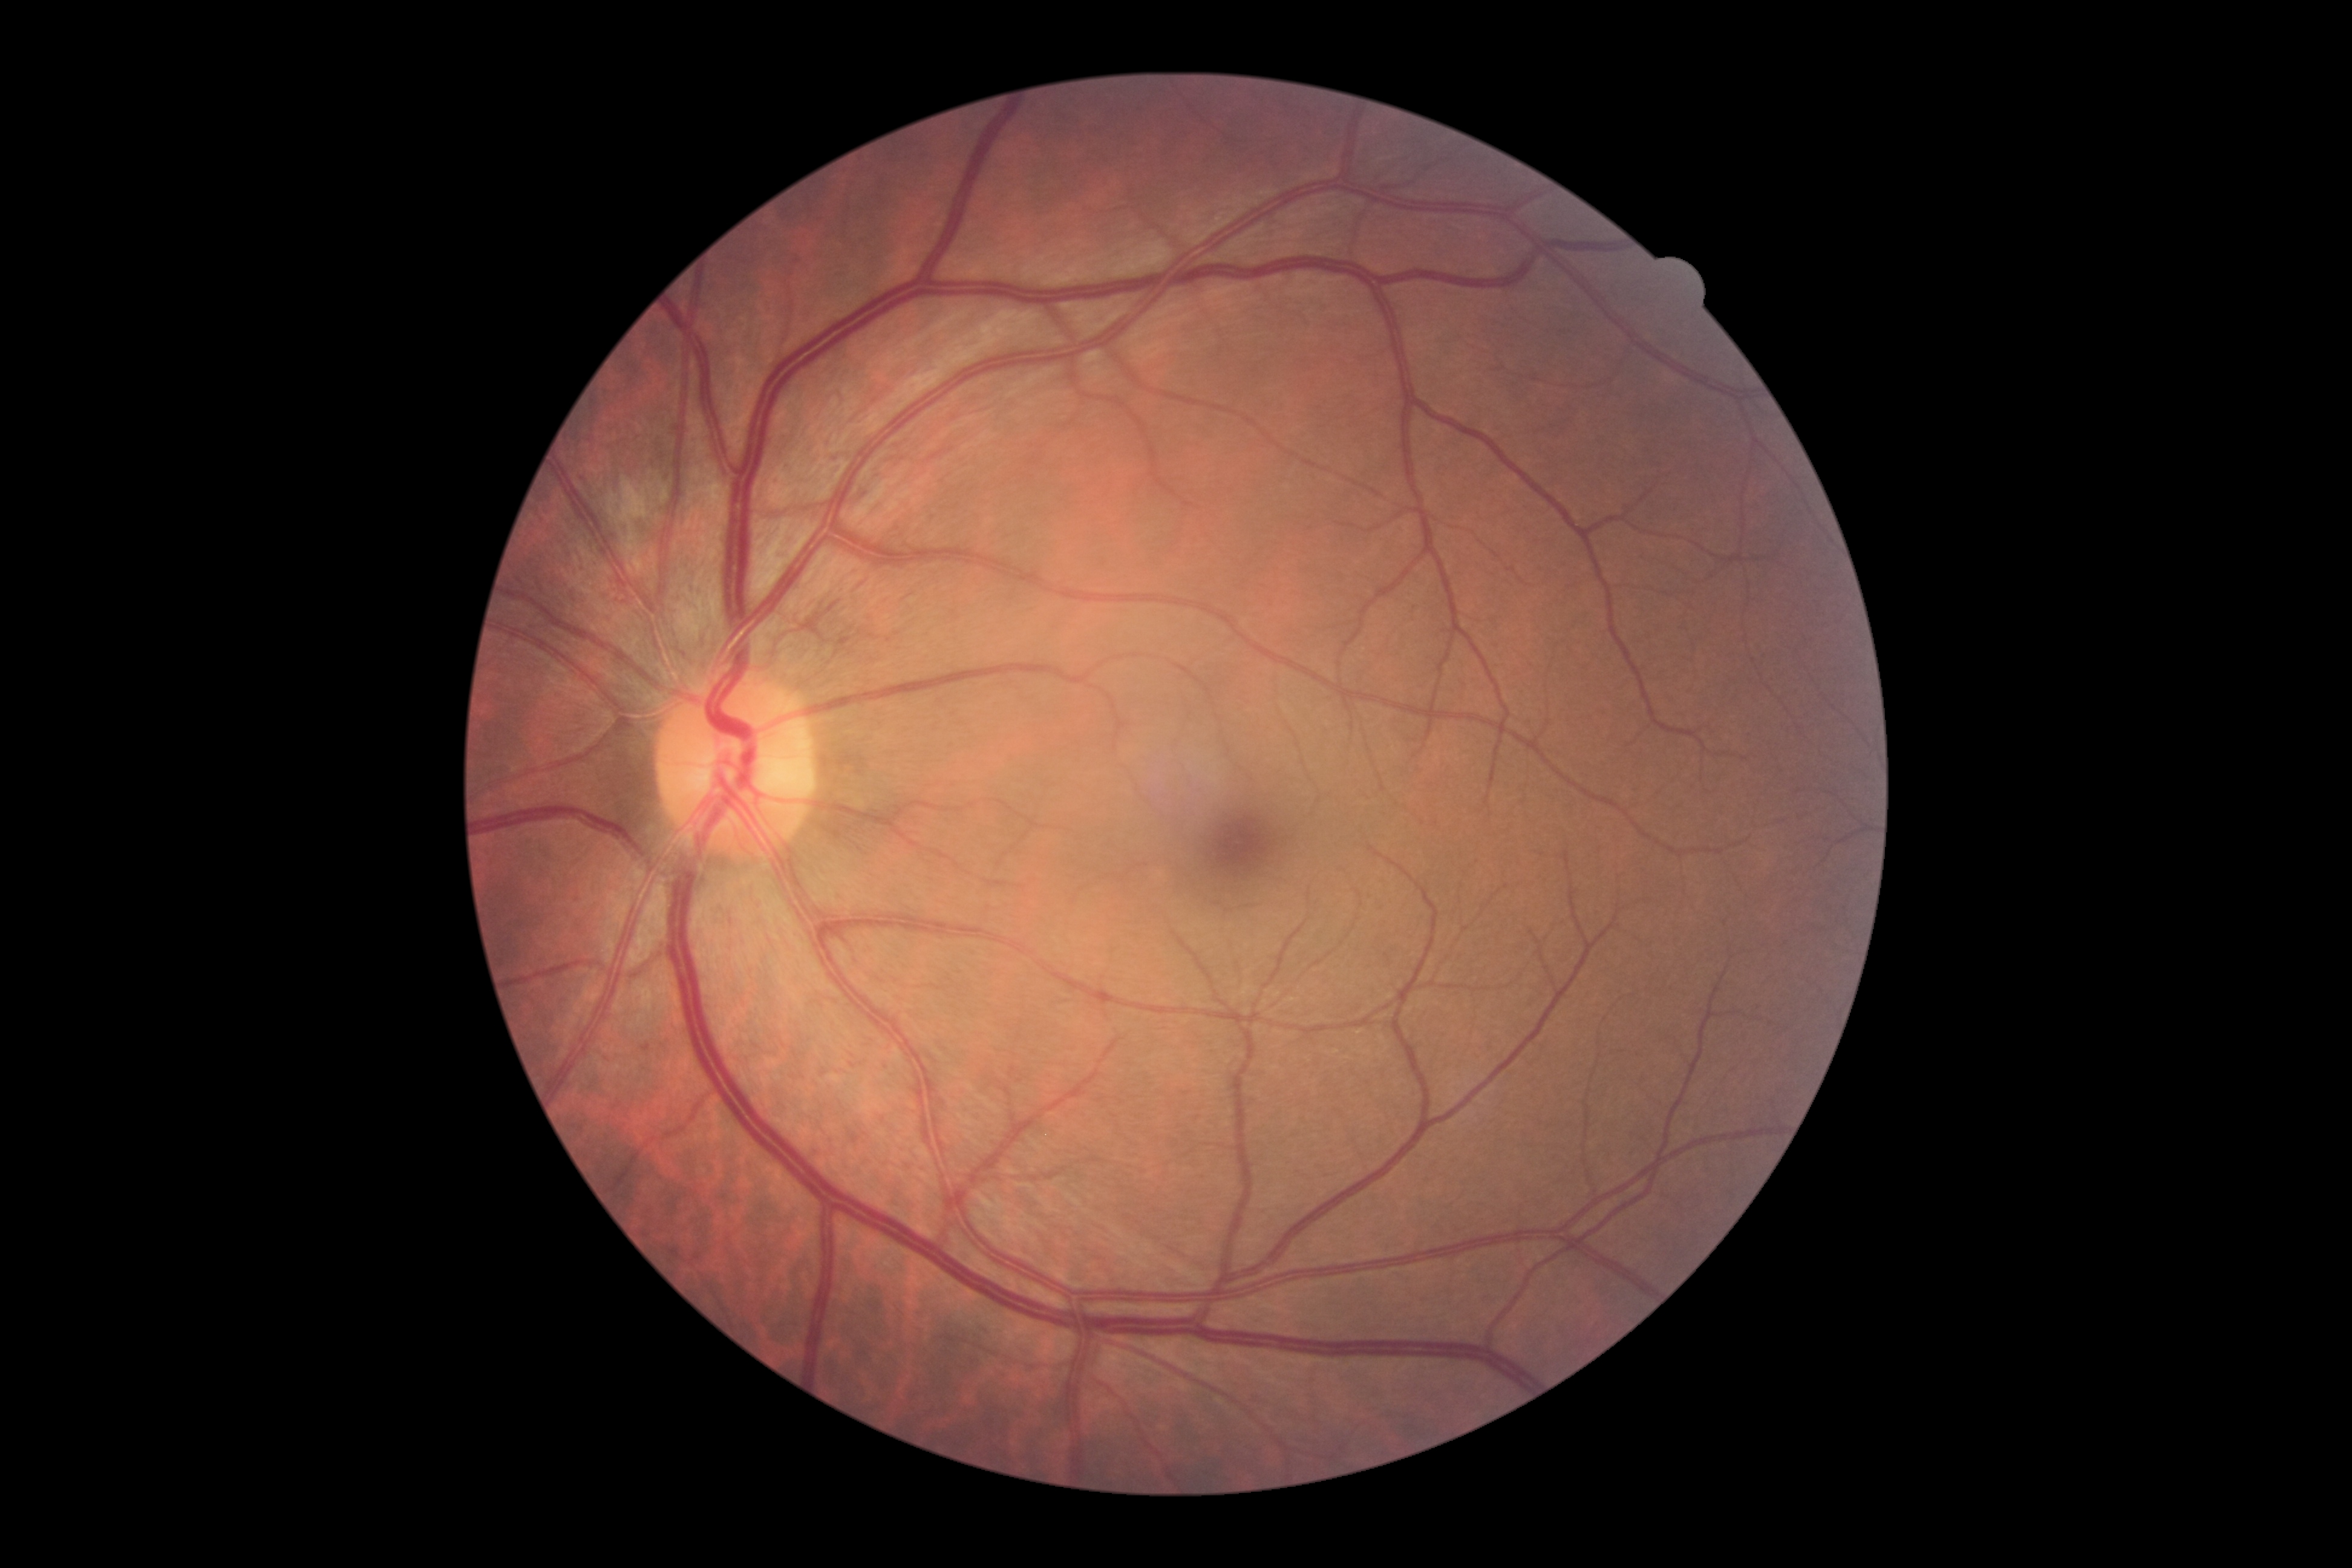

Diabetic retinopathy severity is 0/4.
No signs of diabetic retinopathy.